45-degree field of view · retinal fundus photograph — 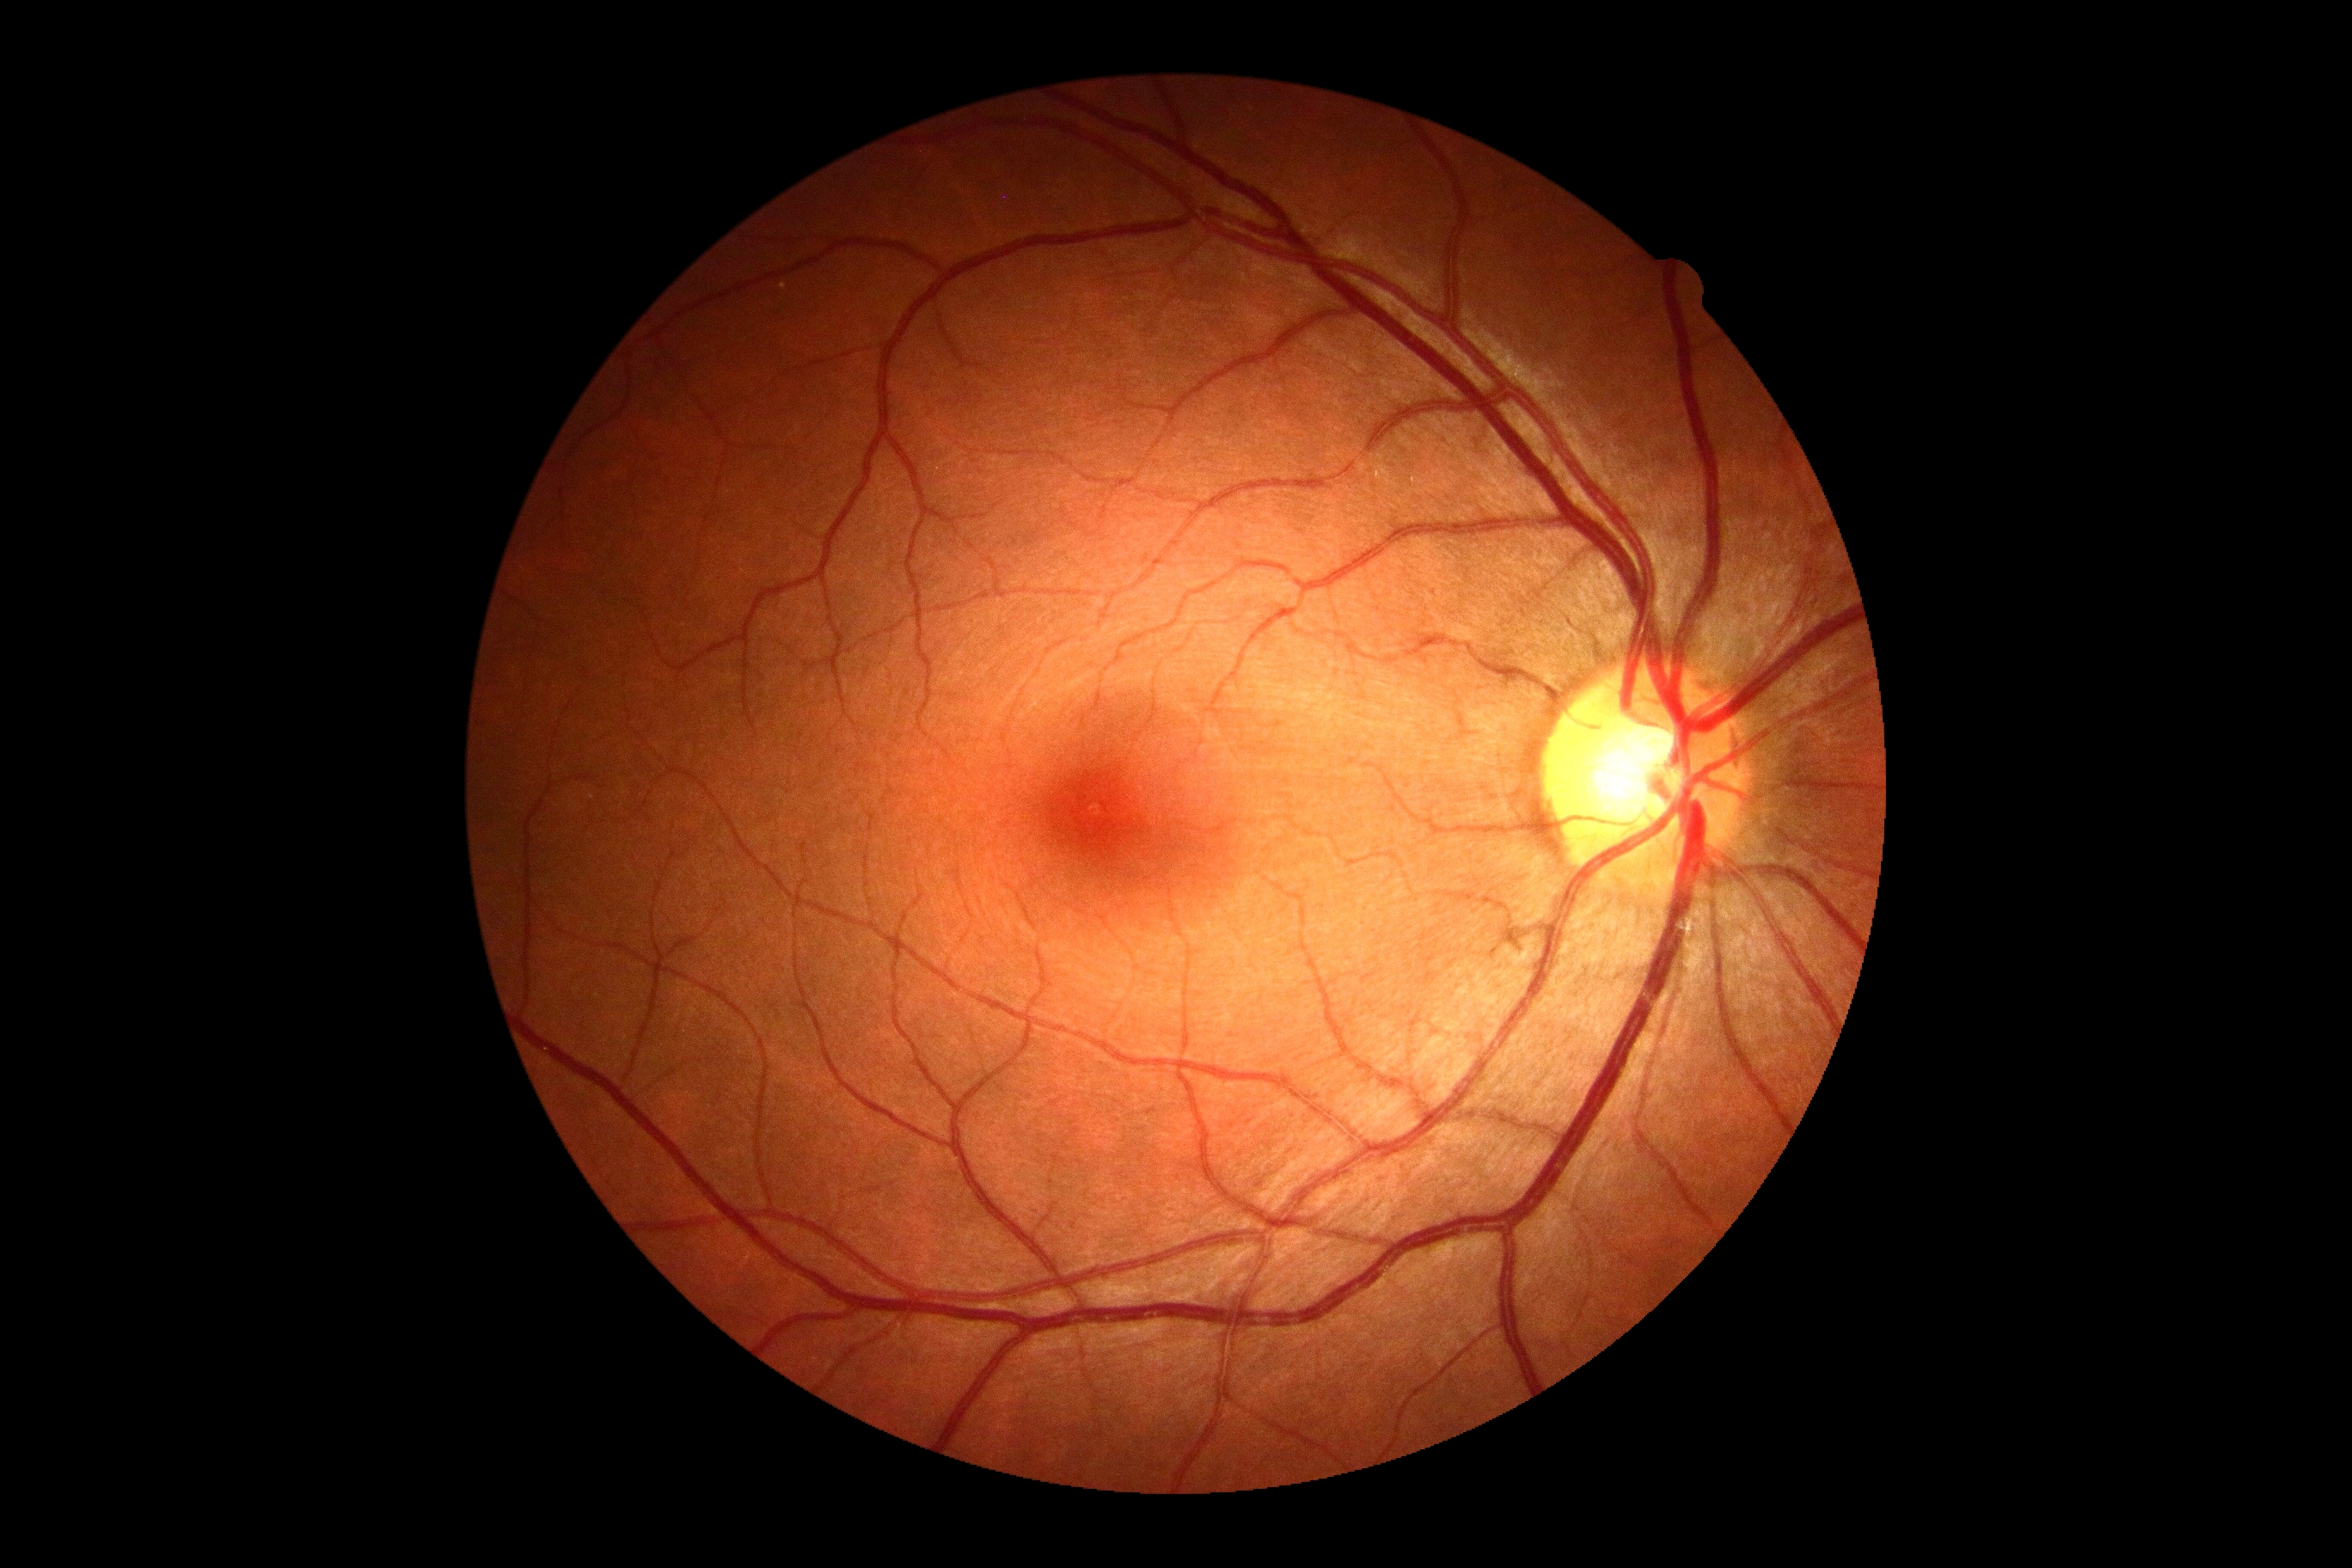
DR stage: grade 0 — no visible signs of diabetic retinopathy.